Canon CR-1.
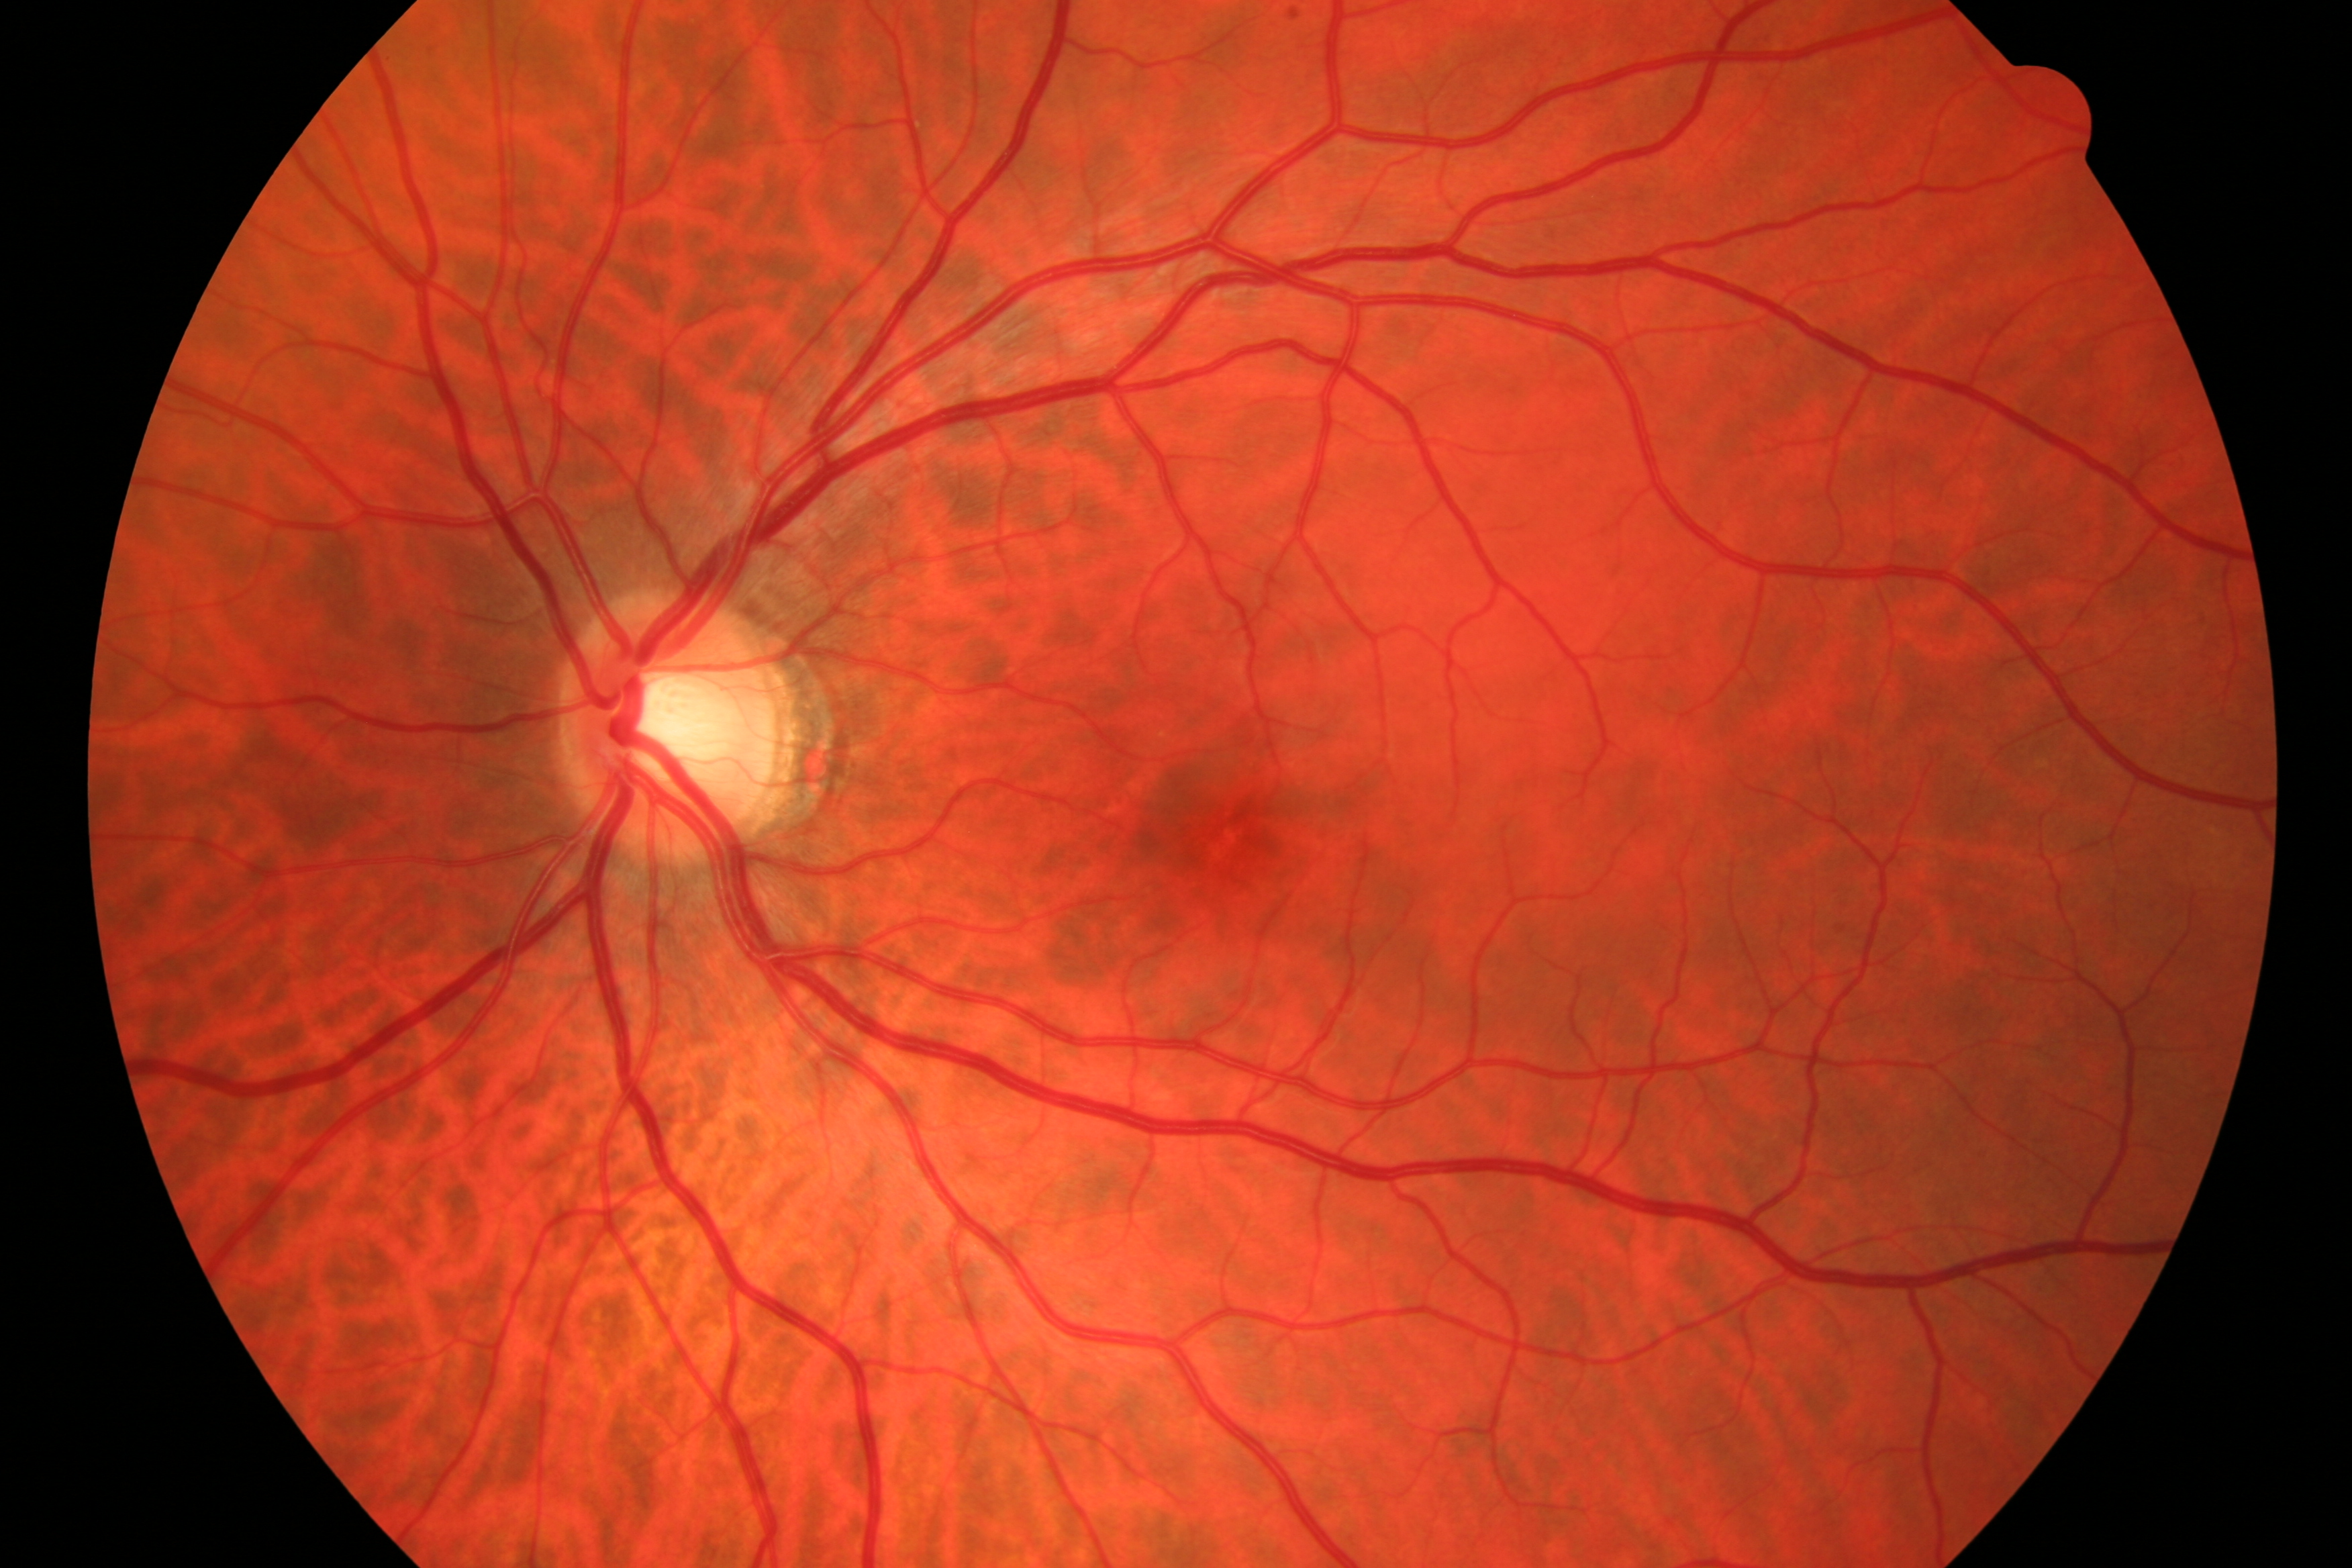

Color fundus photograph with no evidence of diabetic retinopathy or glaucoma.